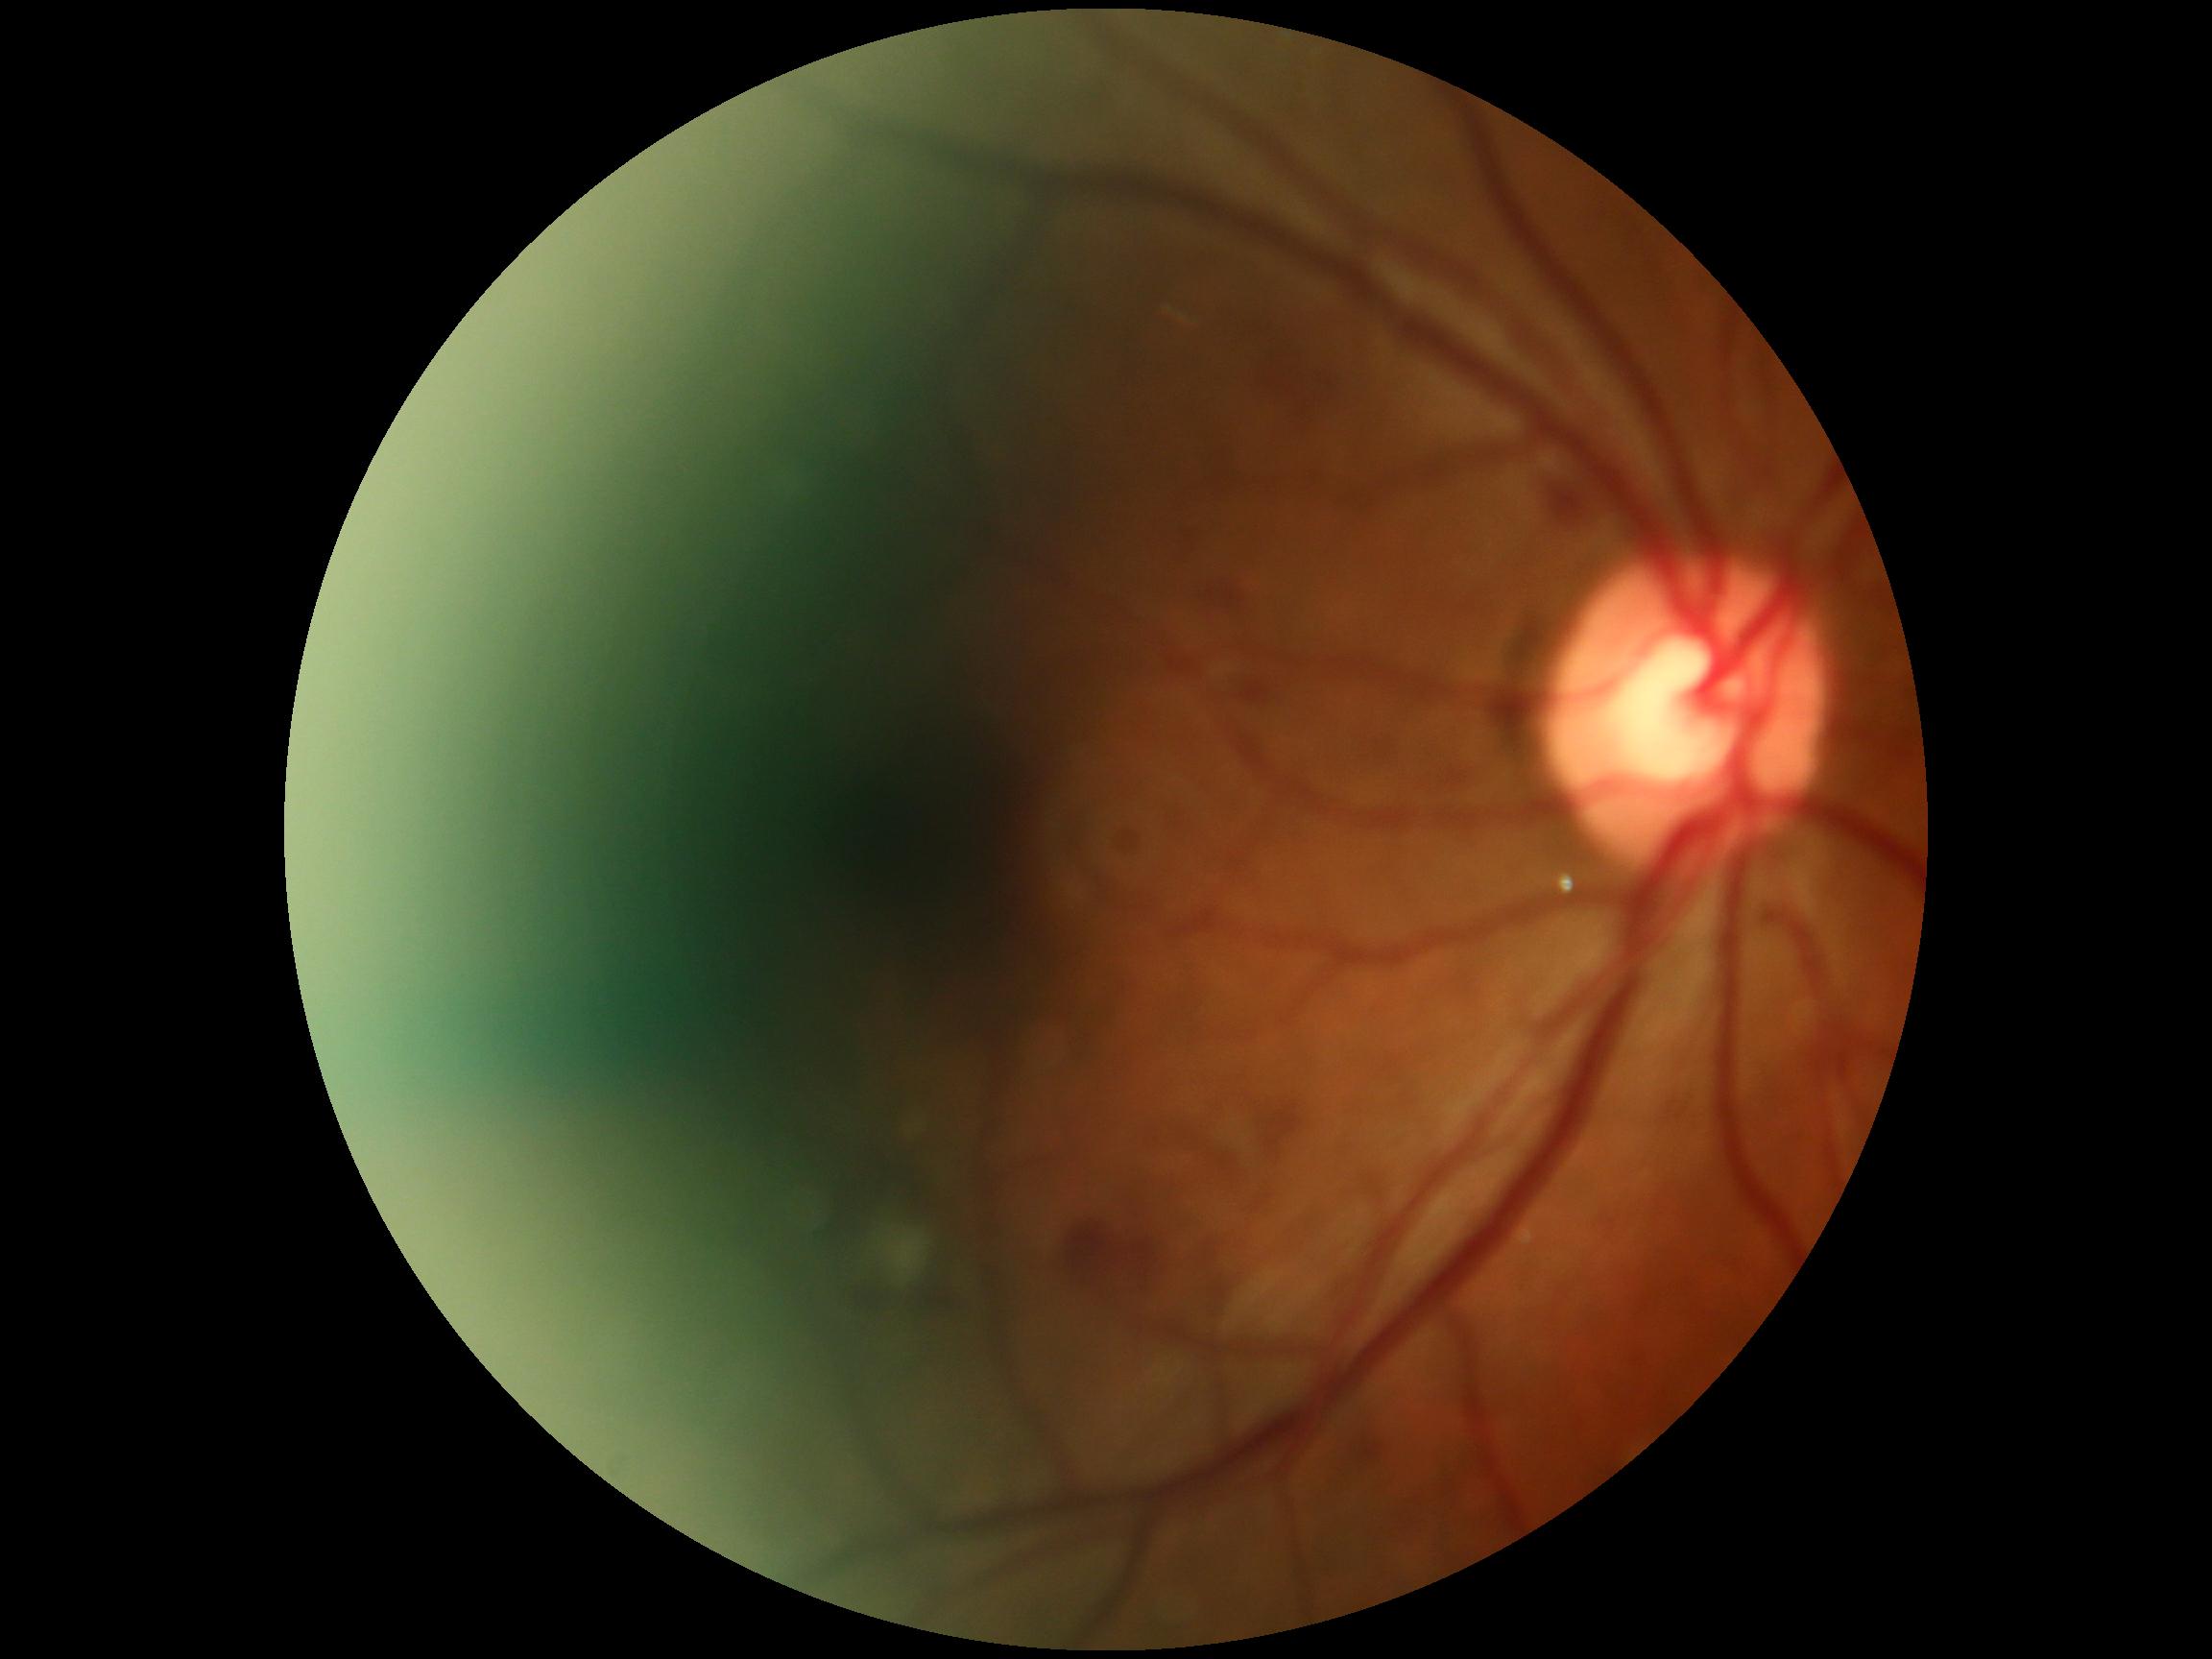

{
  "dr_grade": "moderate NPDR (grade 2) — more than just microaneurysms but less than severe NPDR"
}